1725 x 1721 pixels; color fundus image; 45° field of view
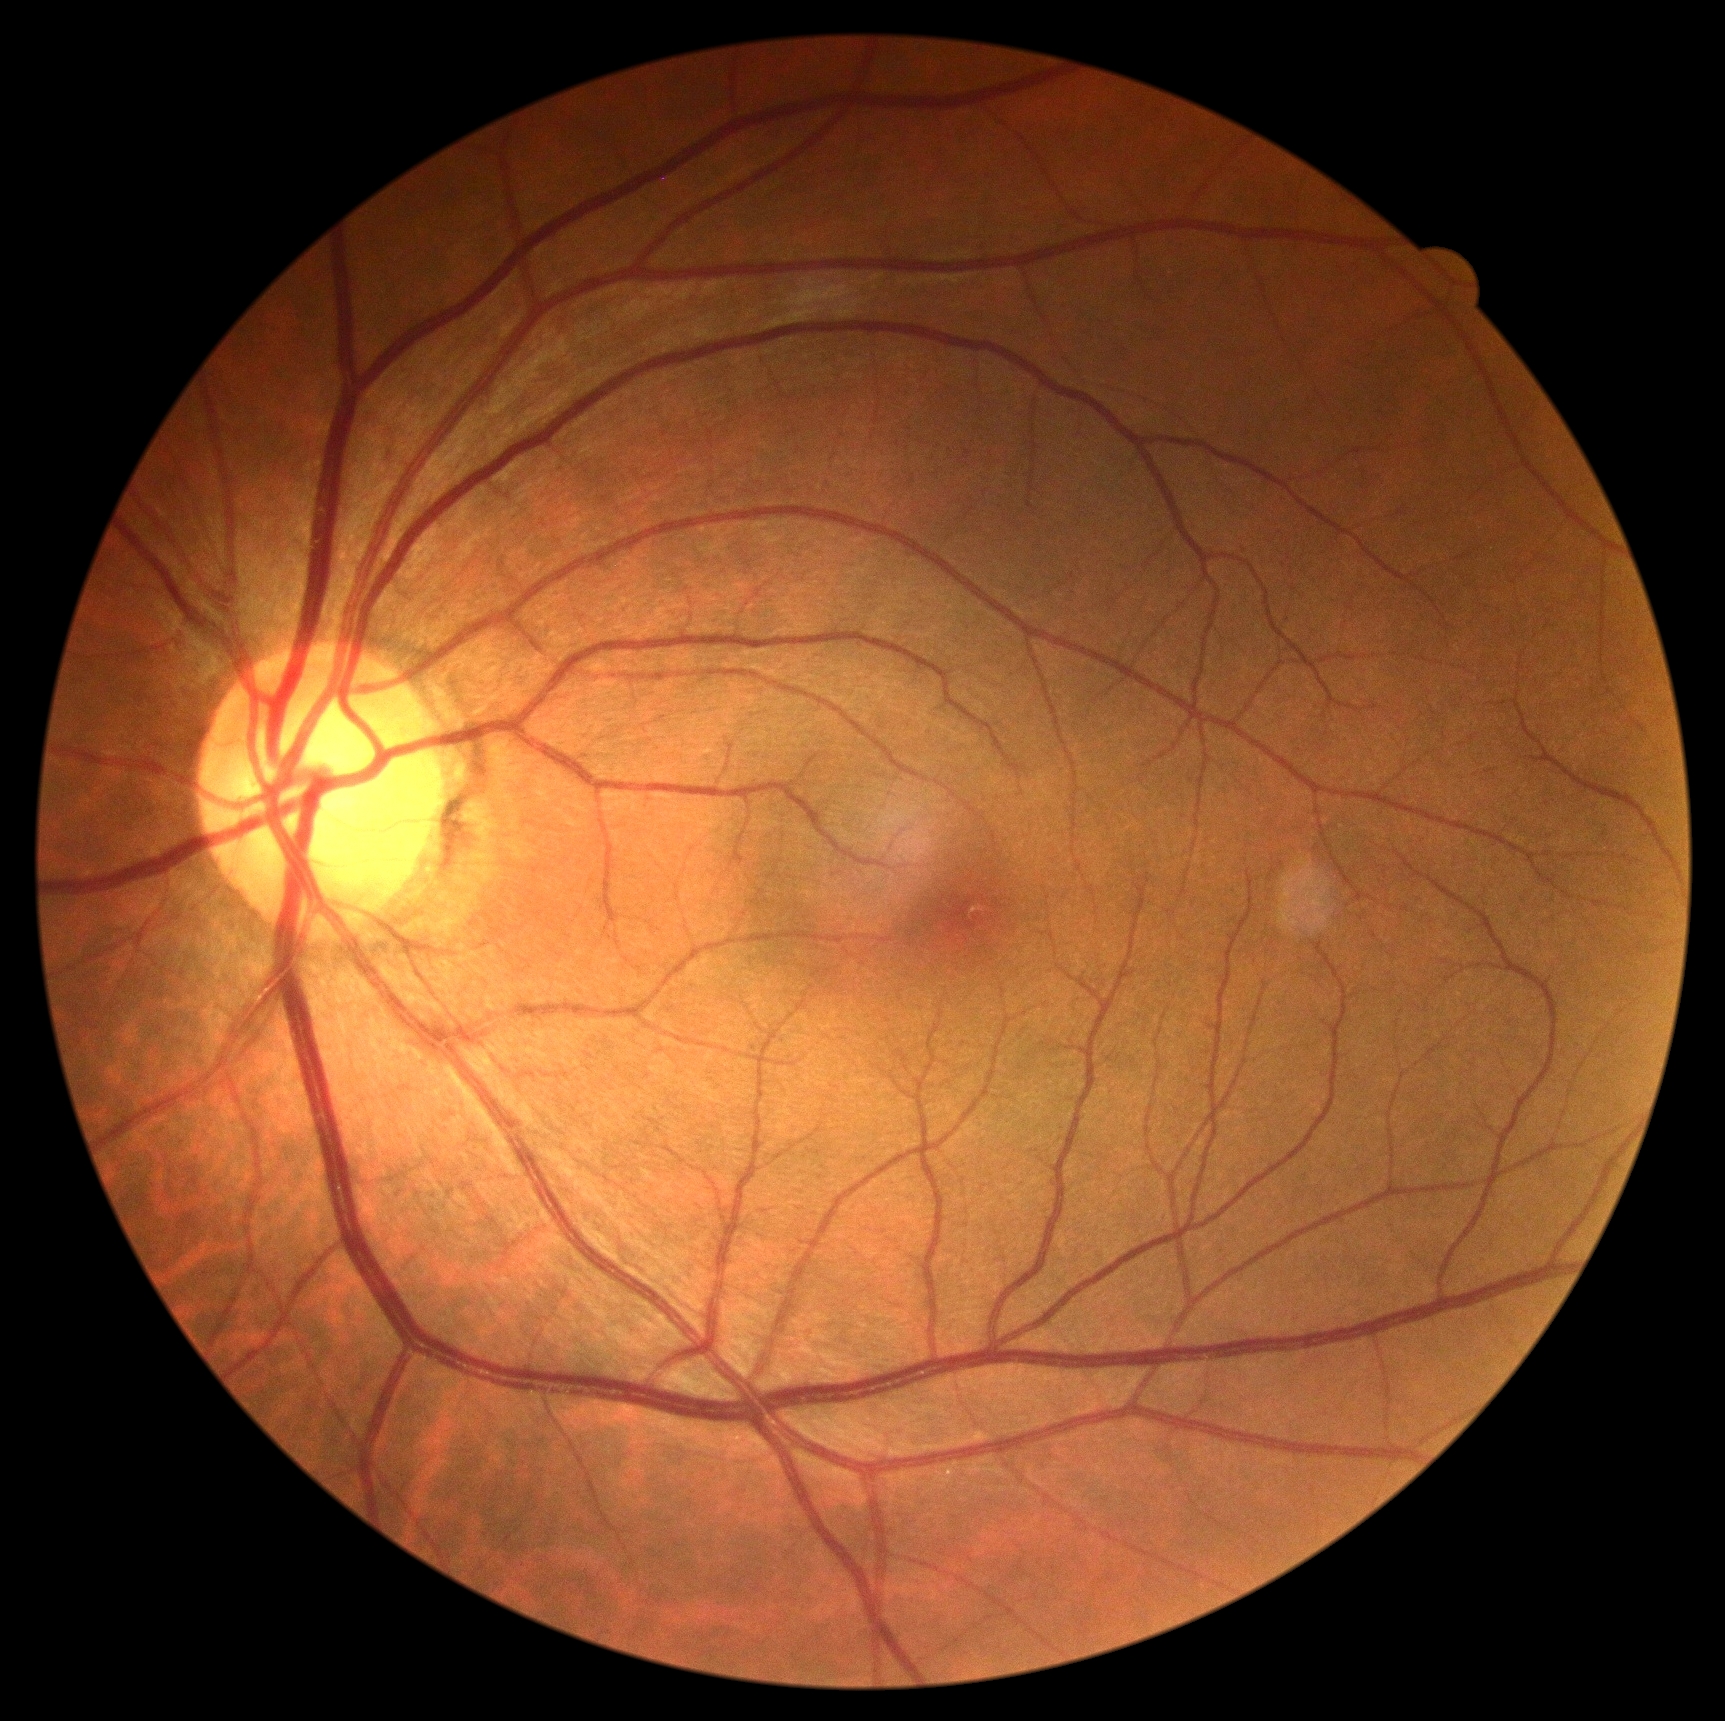 Diabetic retinopathy is no apparent diabetic retinopathy (grade 0). No signs of diabetic retinopathy.